Infant wide-field fundus photograph.
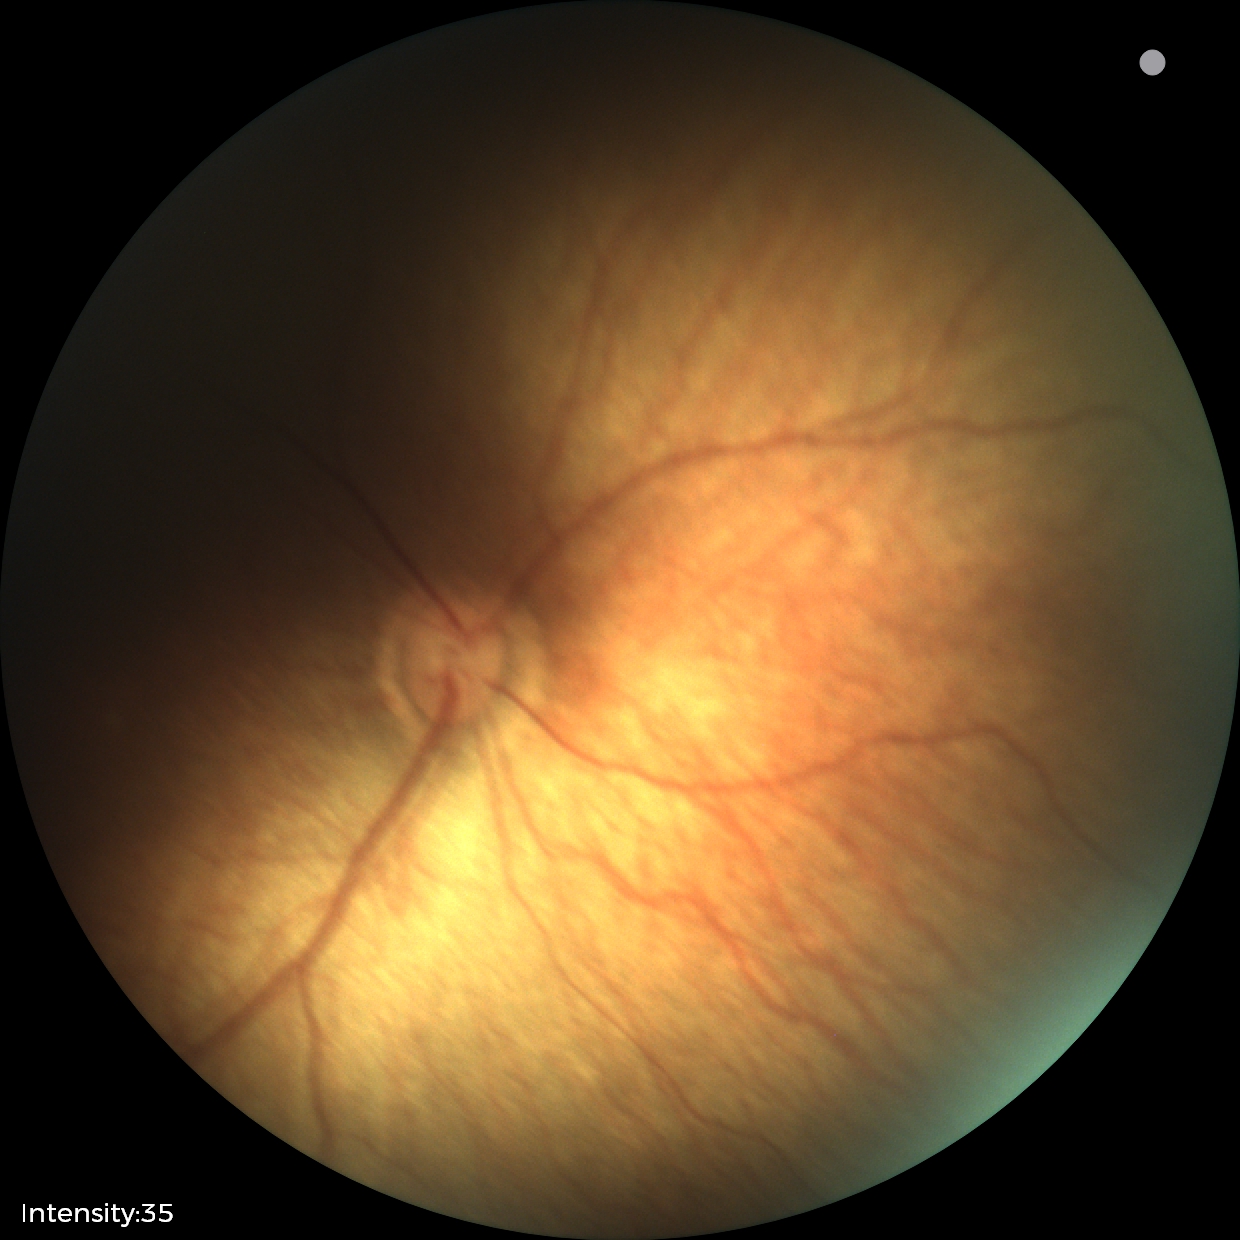
Screening examination with no abnormal retinal findings.